FOV: 45 degrees
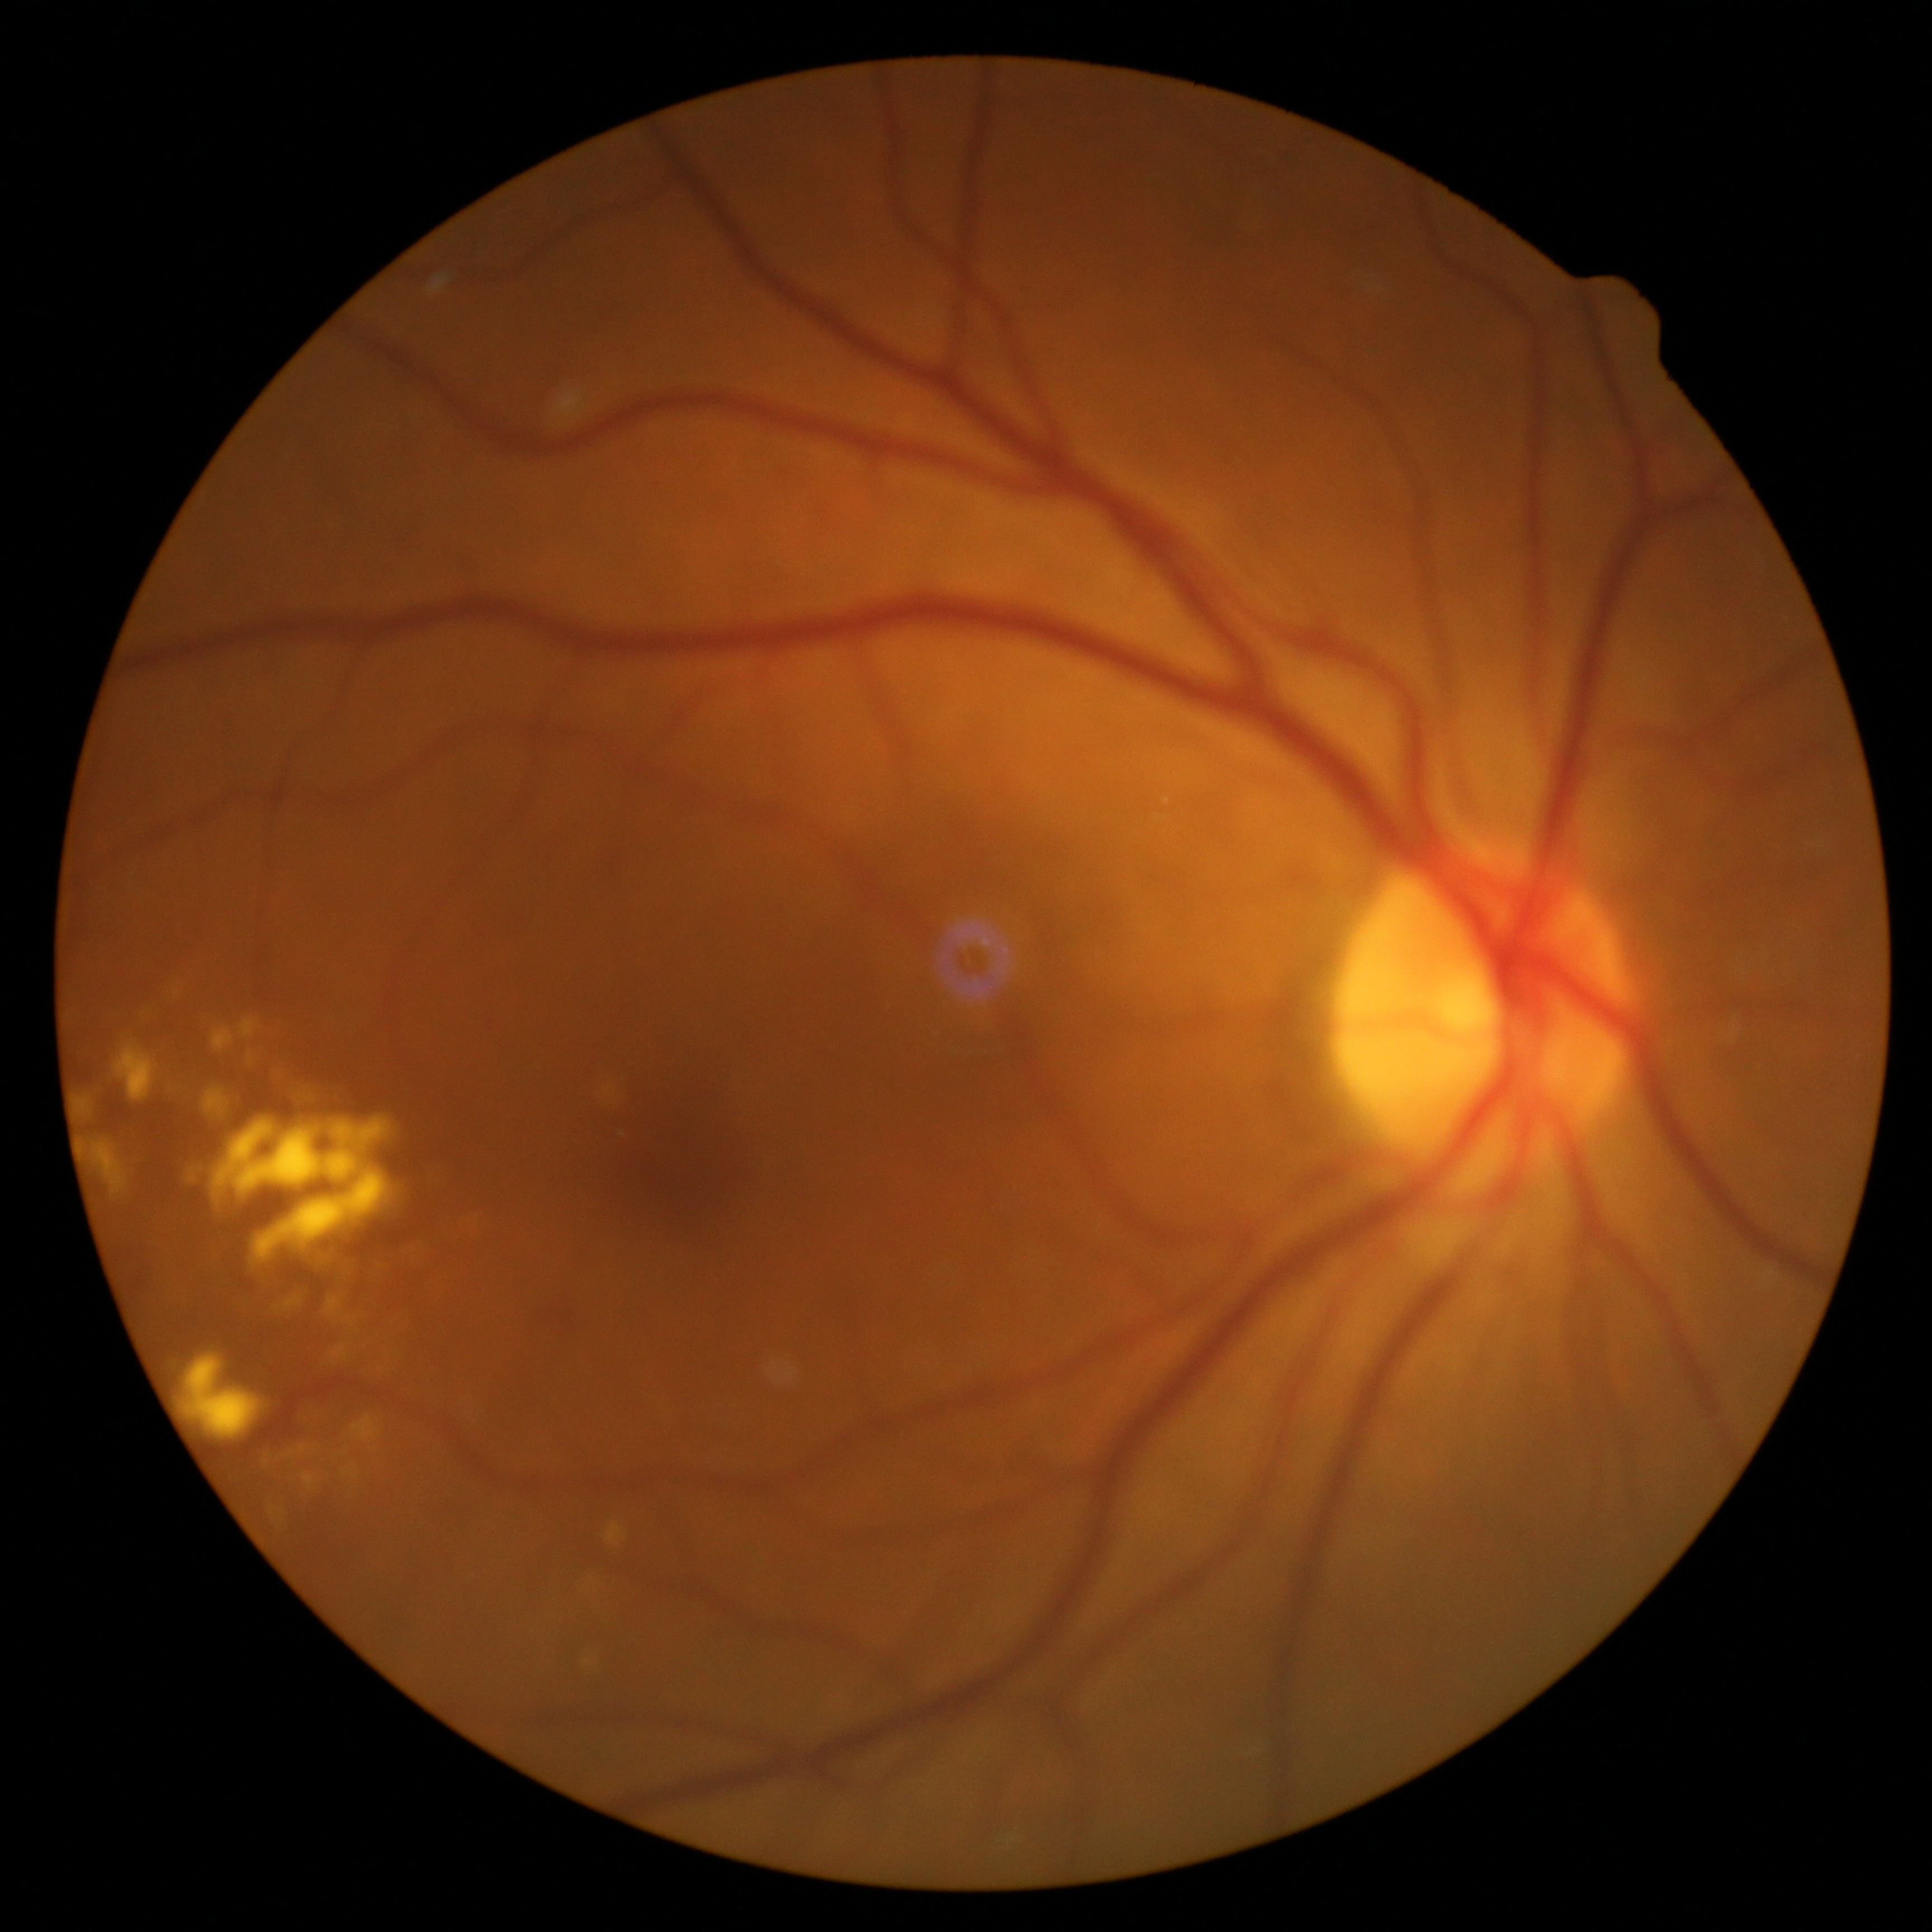

{"dr_grade": "moderate non-proliferative diabetic retinopathy (grade 2)"}